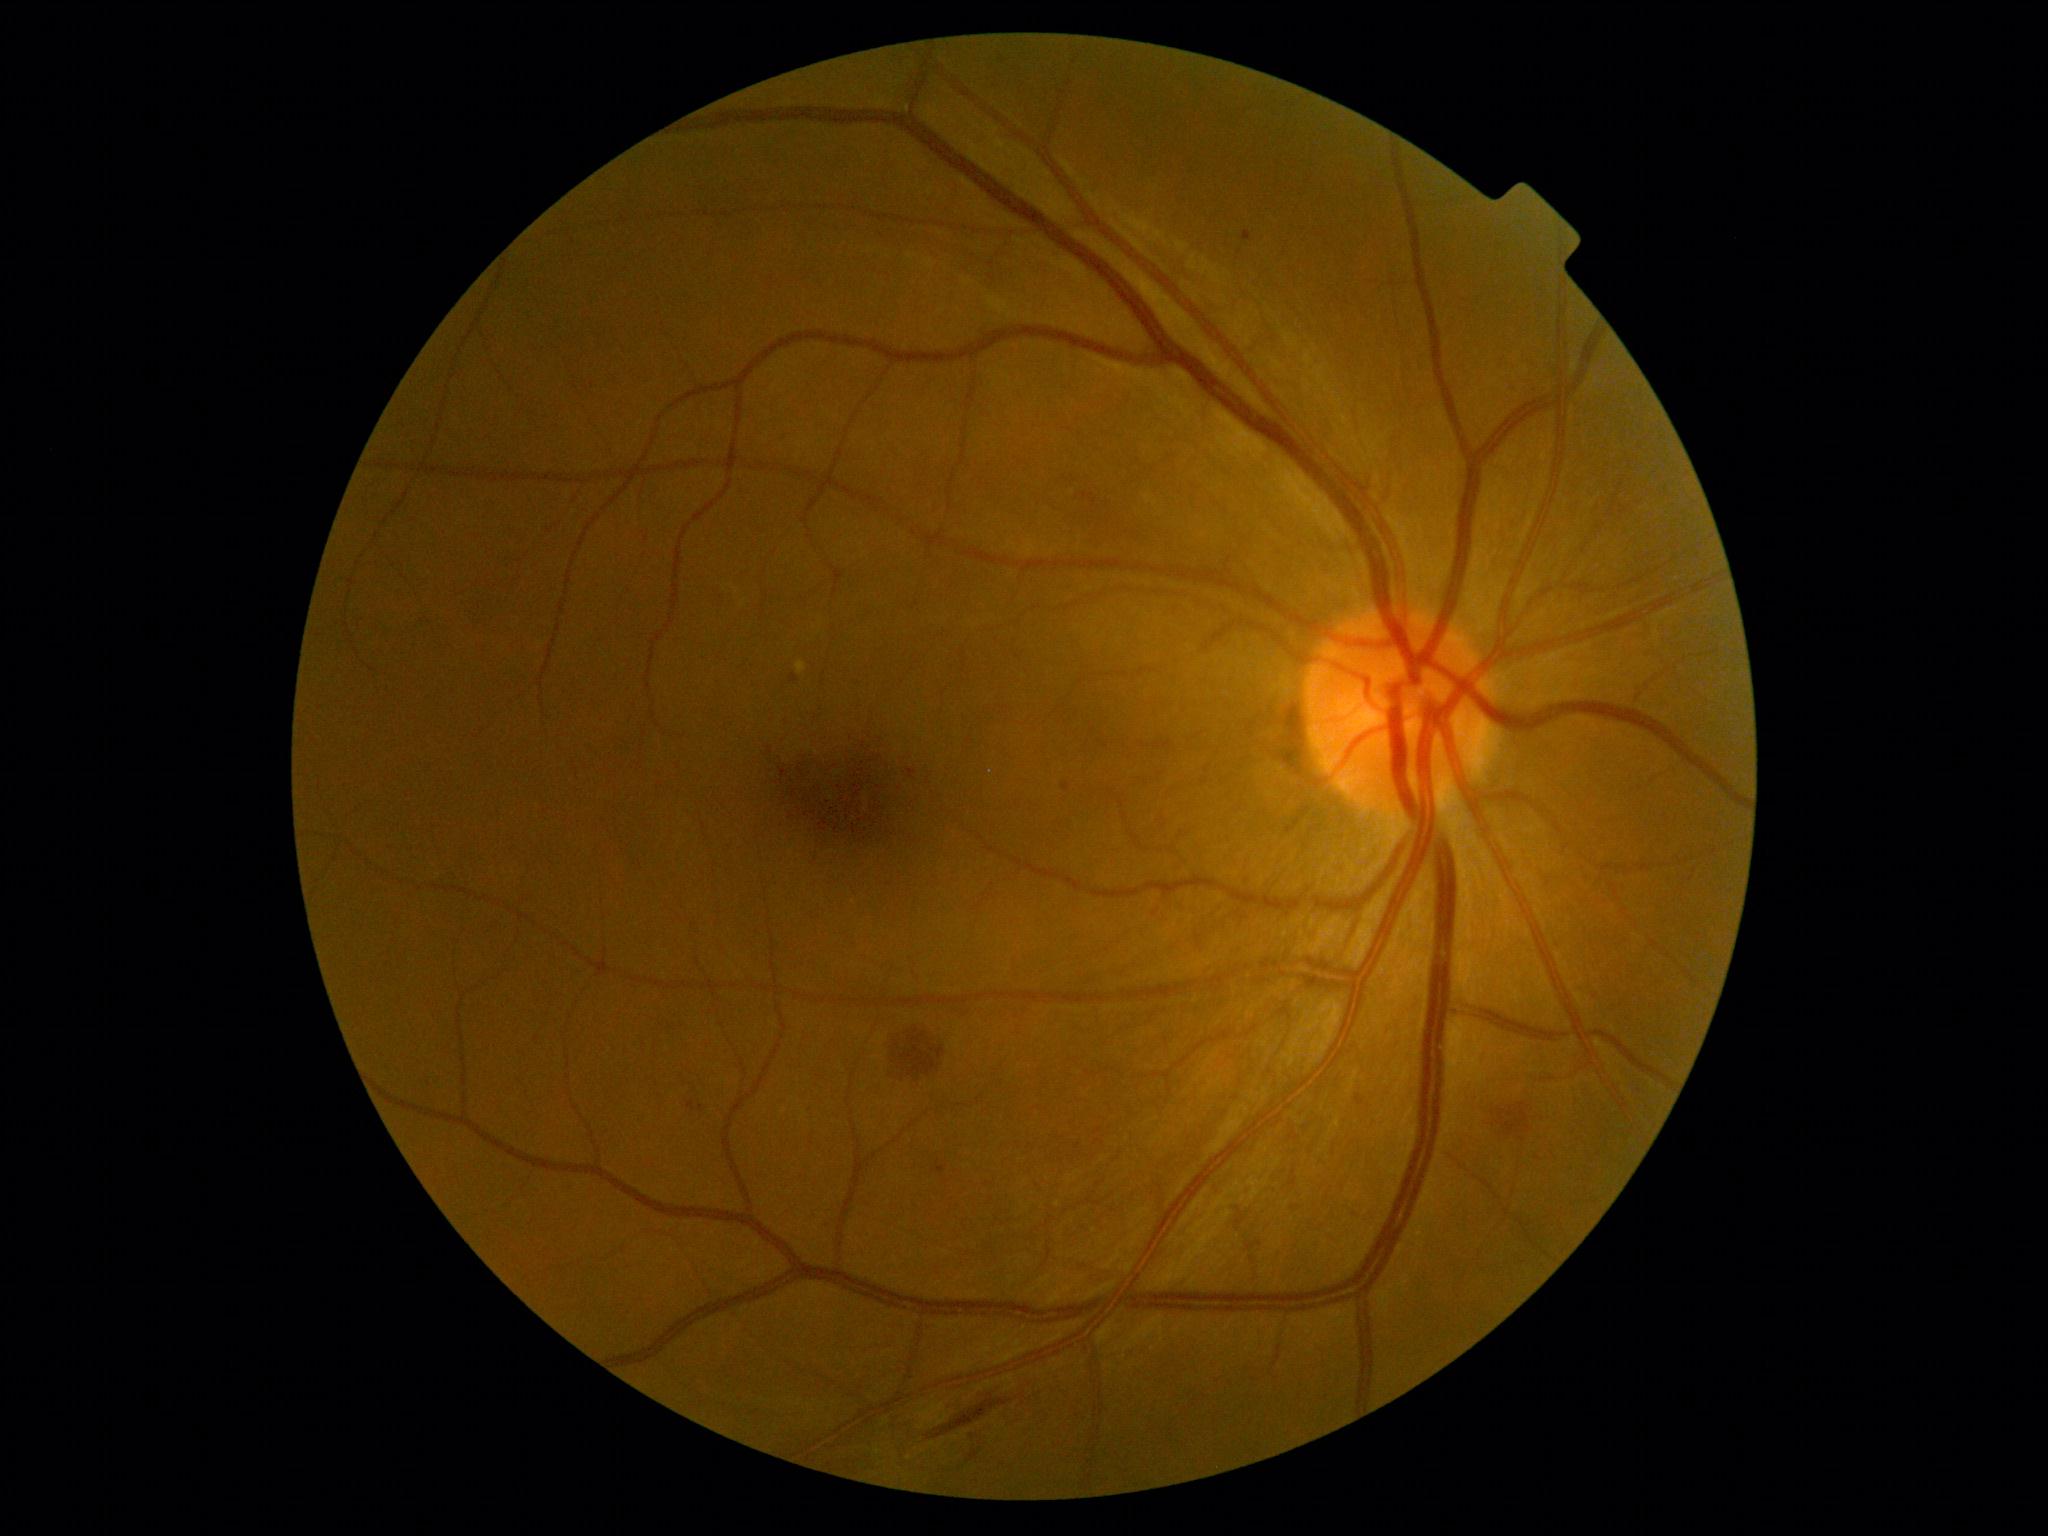 DR severity: 2/4. Disease class: non-proliferative diabetic retinopathy.